Fundus photo — 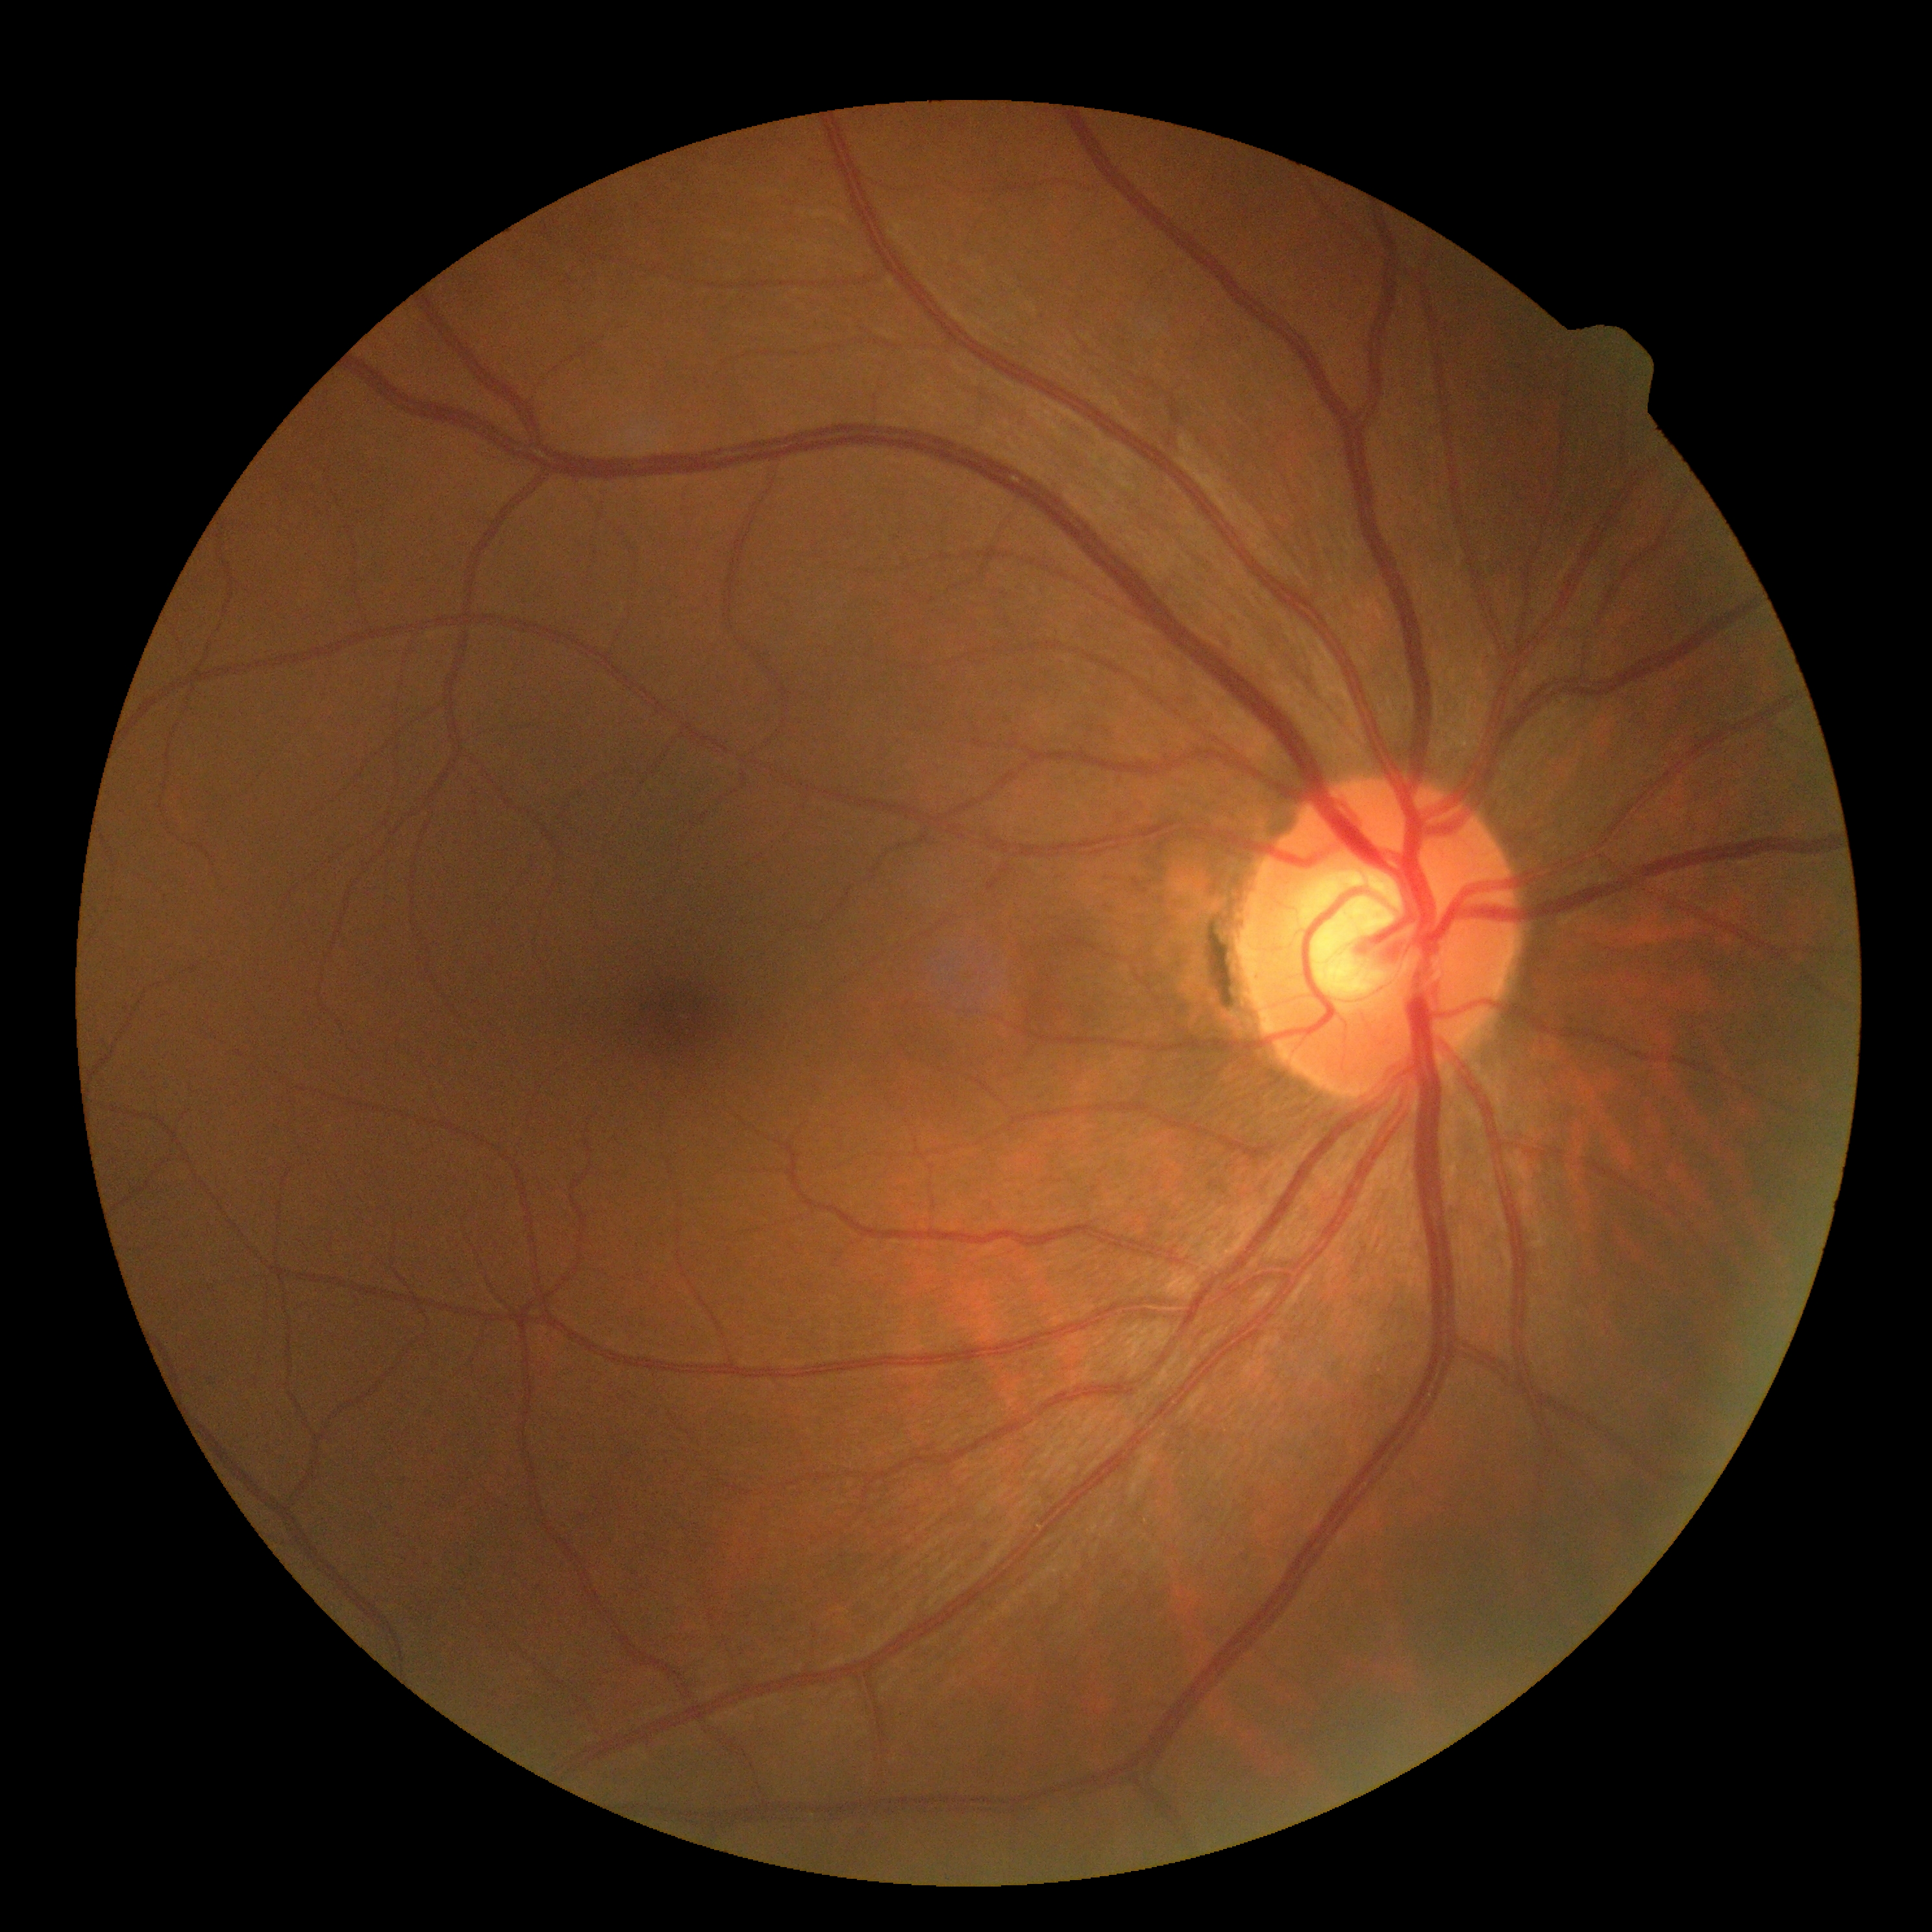

Diabetic retinopathy (DR): 0.